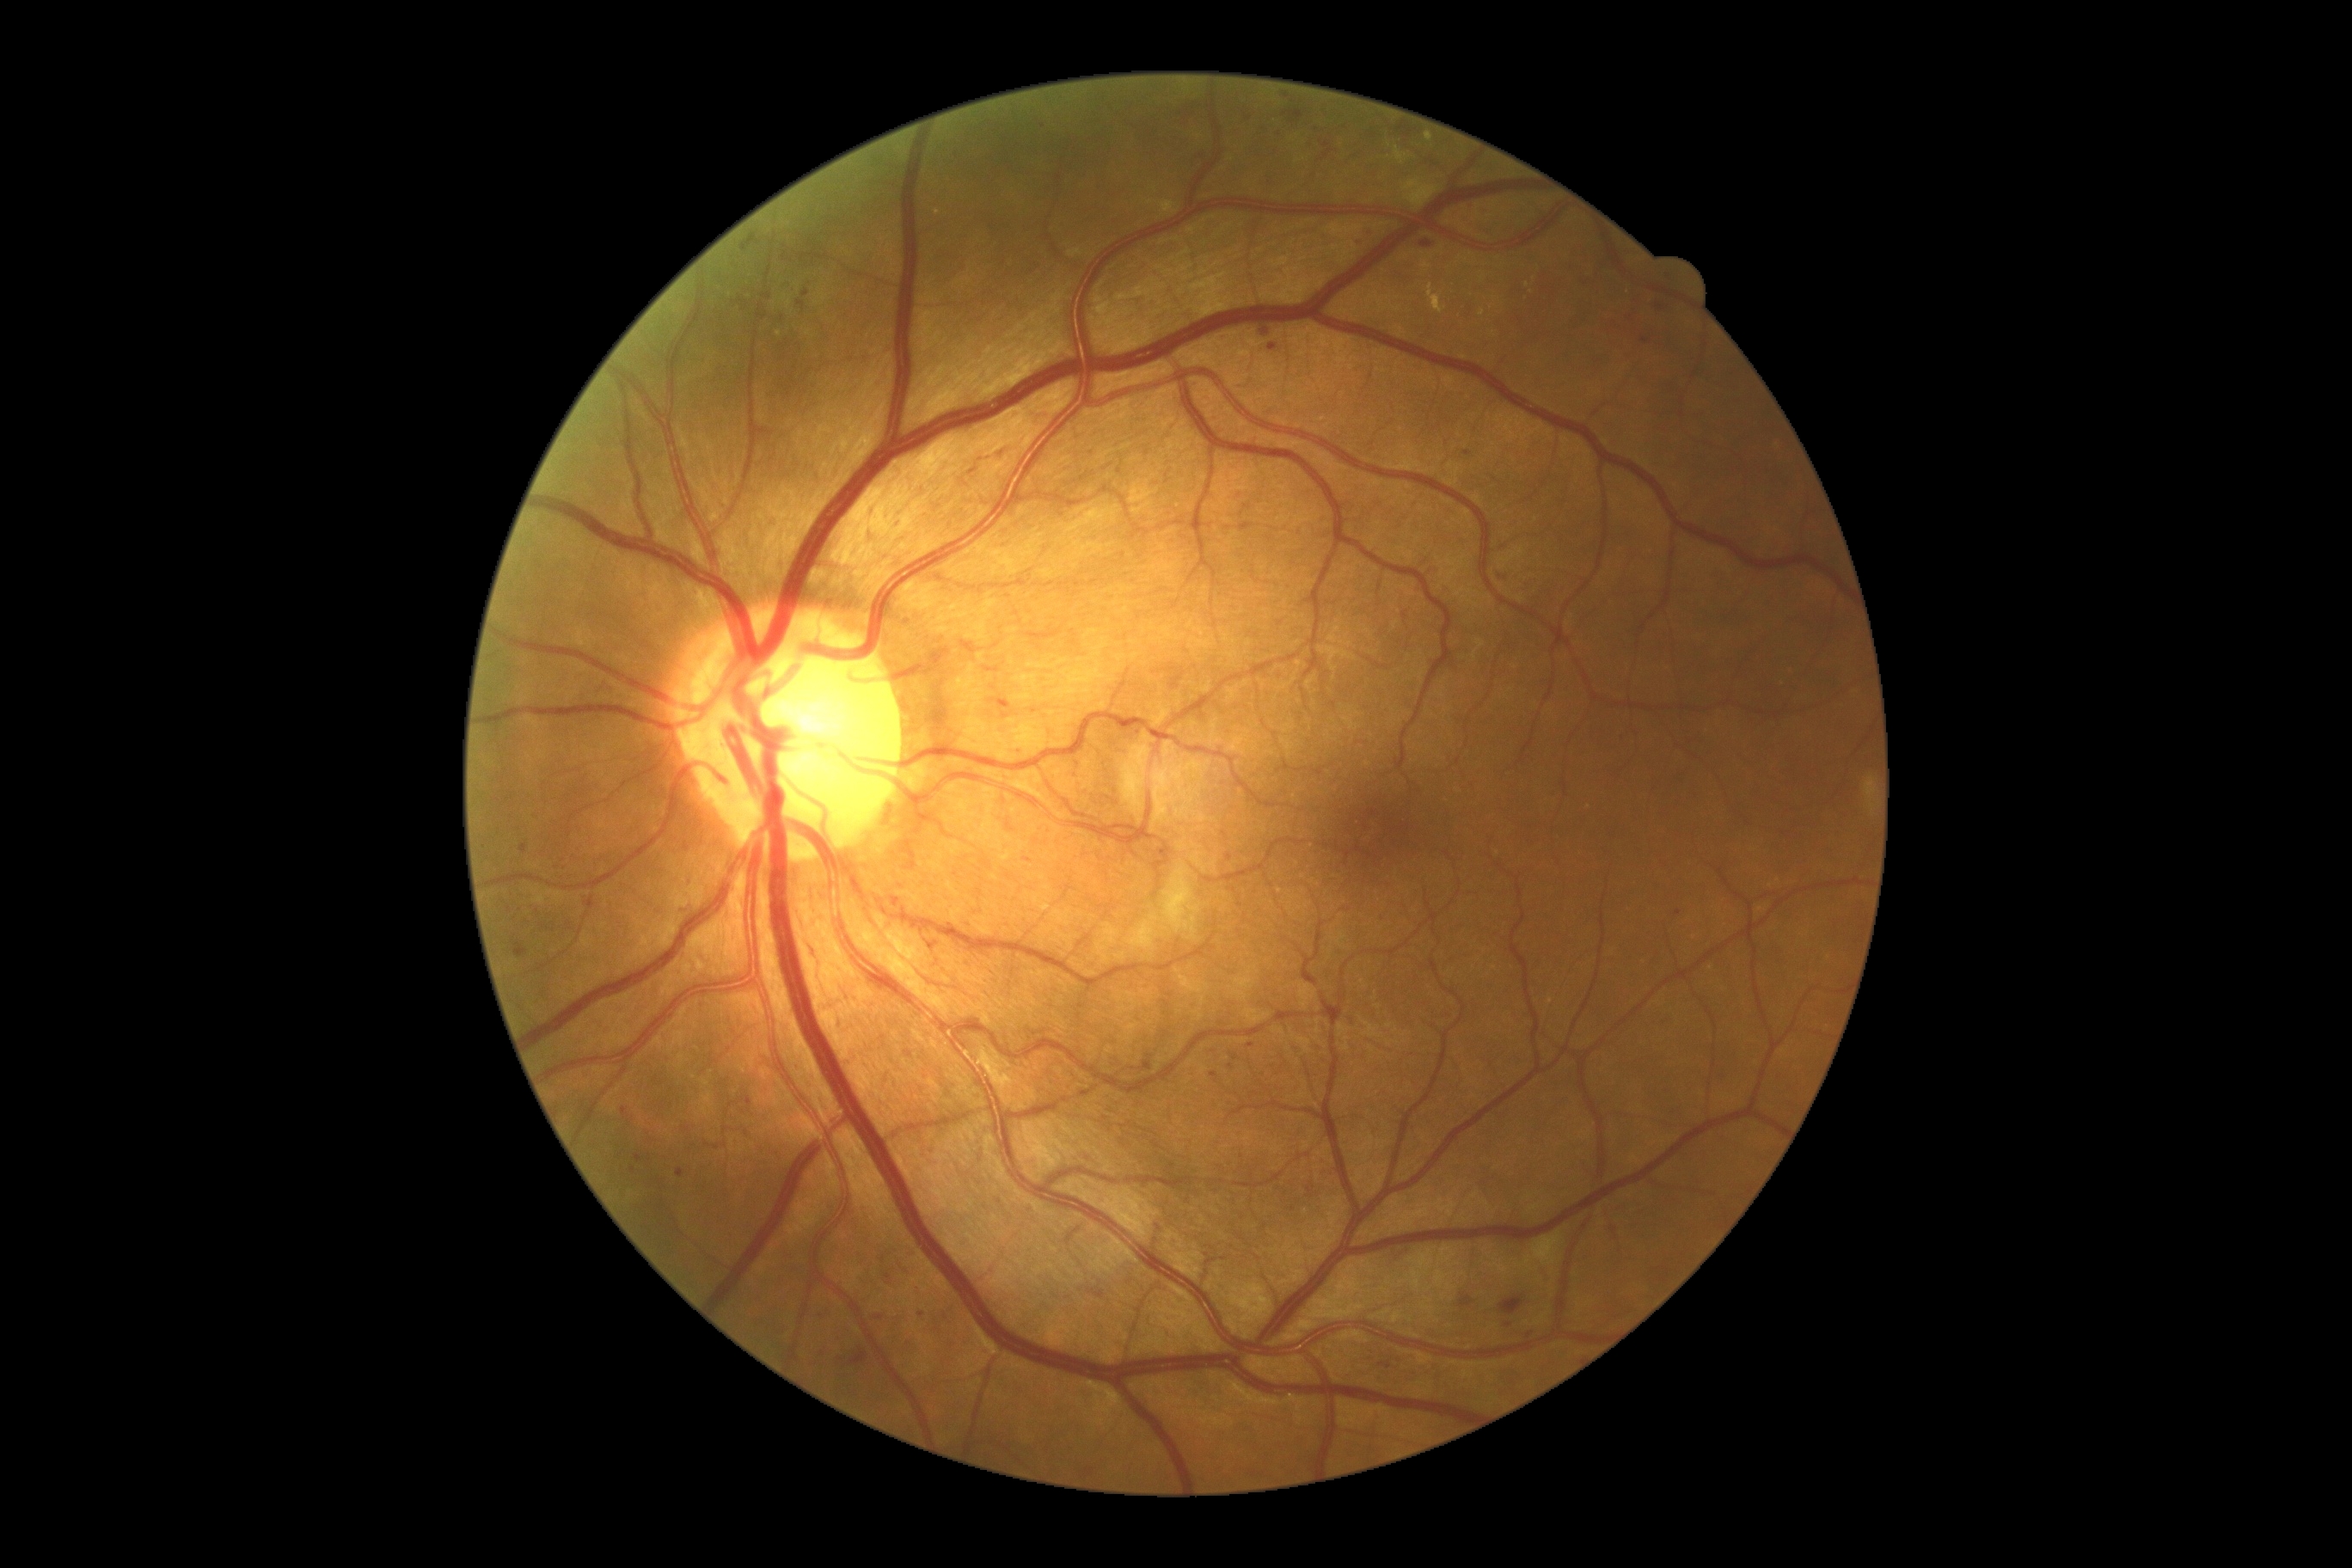
Diabetic retinopathy (DR) is 2
A subset of detected lesions:
microaneurysms (MAs) (continued): bbox(745, 1098, 752, 1106); bbox(1024, 859, 1032, 864); bbox(1261, 328, 1270, 336); bbox(1421, 240, 1433, 248); bbox(1282, 109, 1304, 125); bbox(513, 941, 527, 959)
Smaller MAs around <pt>1319,772</pt>; <pt>1120,471</pt>; <pt>1232,1067</pt>; <pt>805,293</pt>; <pt>1622,741</pt>; <pt>922,1315</pt>; <pt>1233,891</pt>; <pt>509,910</pt>; <pt>824,1354</pt>; <pt>1316,128</pt>